FOV: 45 degrees
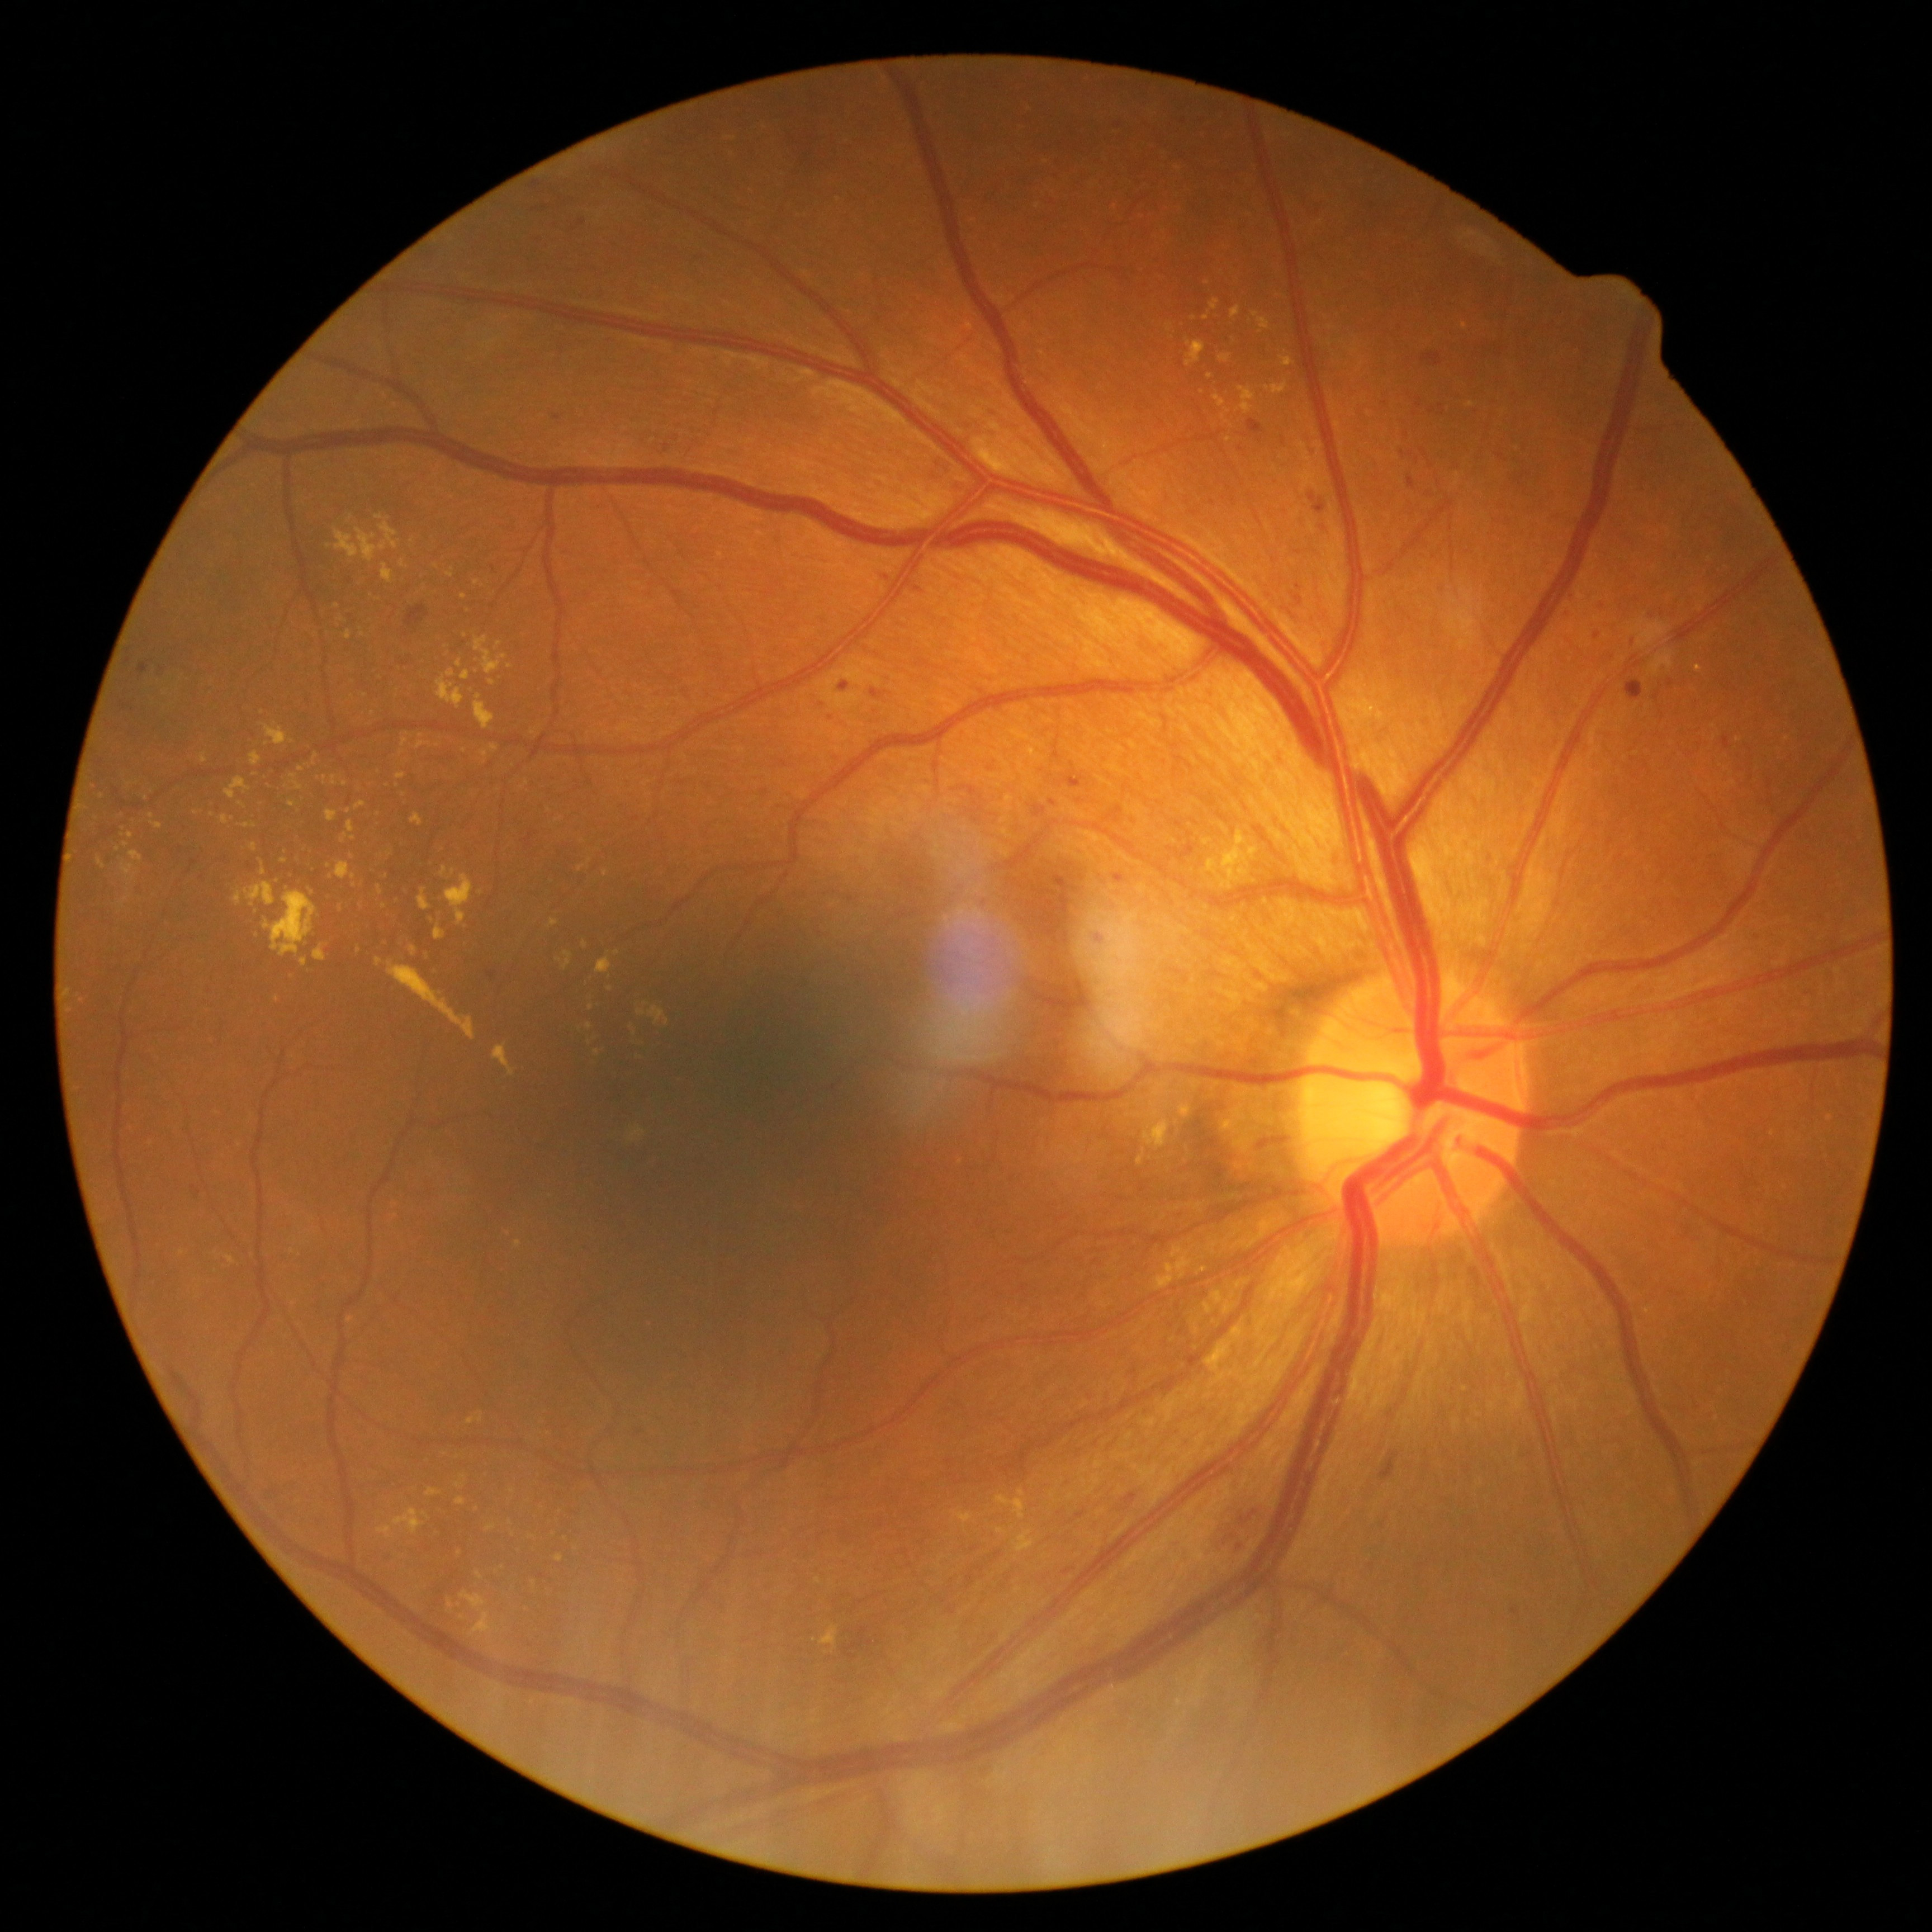
Diabetic retinopathy grade: moderate non-proliferative diabetic retinopathy (2) — more than just microaneurysms but less than severe NPDR
Selected lesions:
microaneurysms (more not shown): {"x1": 139, "y1": 662, "x2": 148, "y2": 676}; {"x1": 840, "y1": 683, "x2": 849, "y2": 692}; {"x1": 1053, "y1": 873, "x2": 1076, "y2": 893}; {"x1": 1035, "y1": 804, "x2": 1047, "y2": 818}; {"x1": 1248, "y1": 420, "x2": 1263, "y2": 434}; {"x1": 1050, "y1": 799, "x2": 1057, "y2": 807}; {"x1": 1408, "y1": 476, "x2": 1416, "y2": 488}; {"x1": 119, "y1": 700, "x2": 131, "y2": 712}; {"x1": 1654, "y1": 692, "x2": 1662, "y2": 700}; {"x1": 914, "y1": 588, "x2": 924, "y2": 594}; {"x1": 1511, "y1": 1608, "x2": 1520, "y2": 1615}; {"x1": 1314, "y1": 501, "x2": 1325, "y2": 514}
Additional small microaneurysms near (494; 570); (1671; 682); (1118; 126); (1072; 877); (557; 417); (545; 209); (640; 1432)
hard exudates (more not shown): {"x1": 263, "y1": 889, "x2": 318, "y2": 958}; {"x1": 1239, "y1": 867, "x2": 1248, "y2": 877}; {"x1": 346, "y1": 631, "x2": 353, "y2": 639}; {"x1": 250, "y1": 753, "x2": 263, "y2": 768}; {"x1": 1012, "y1": 1529, "x2": 1035, "y2": 1552}; {"x1": 441, "y1": 866, "x2": 448, "y2": 877}; {"x1": 1207, "y1": 1339, "x2": 1246, "y2": 1367}; {"x1": 130, "y1": 851, "x2": 144, "y2": 863}; {"x1": 456, "y1": 659, "x2": 462, "y2": 668}; {"x1": 121, "y1": 863, "x2": 137, "y2": 882}; {"x1": 1219, "y1": 354, "x2": 1232, "y2": 363}
Additional small hard exudates near (67; 993); (436; 567); (384; 906); (341; 619); (559; 1558); (353; 857); (531; 1536); (302; 769); (590; 861)